Color fundus image; 2352 x 1568 pixels; 45° field of view: 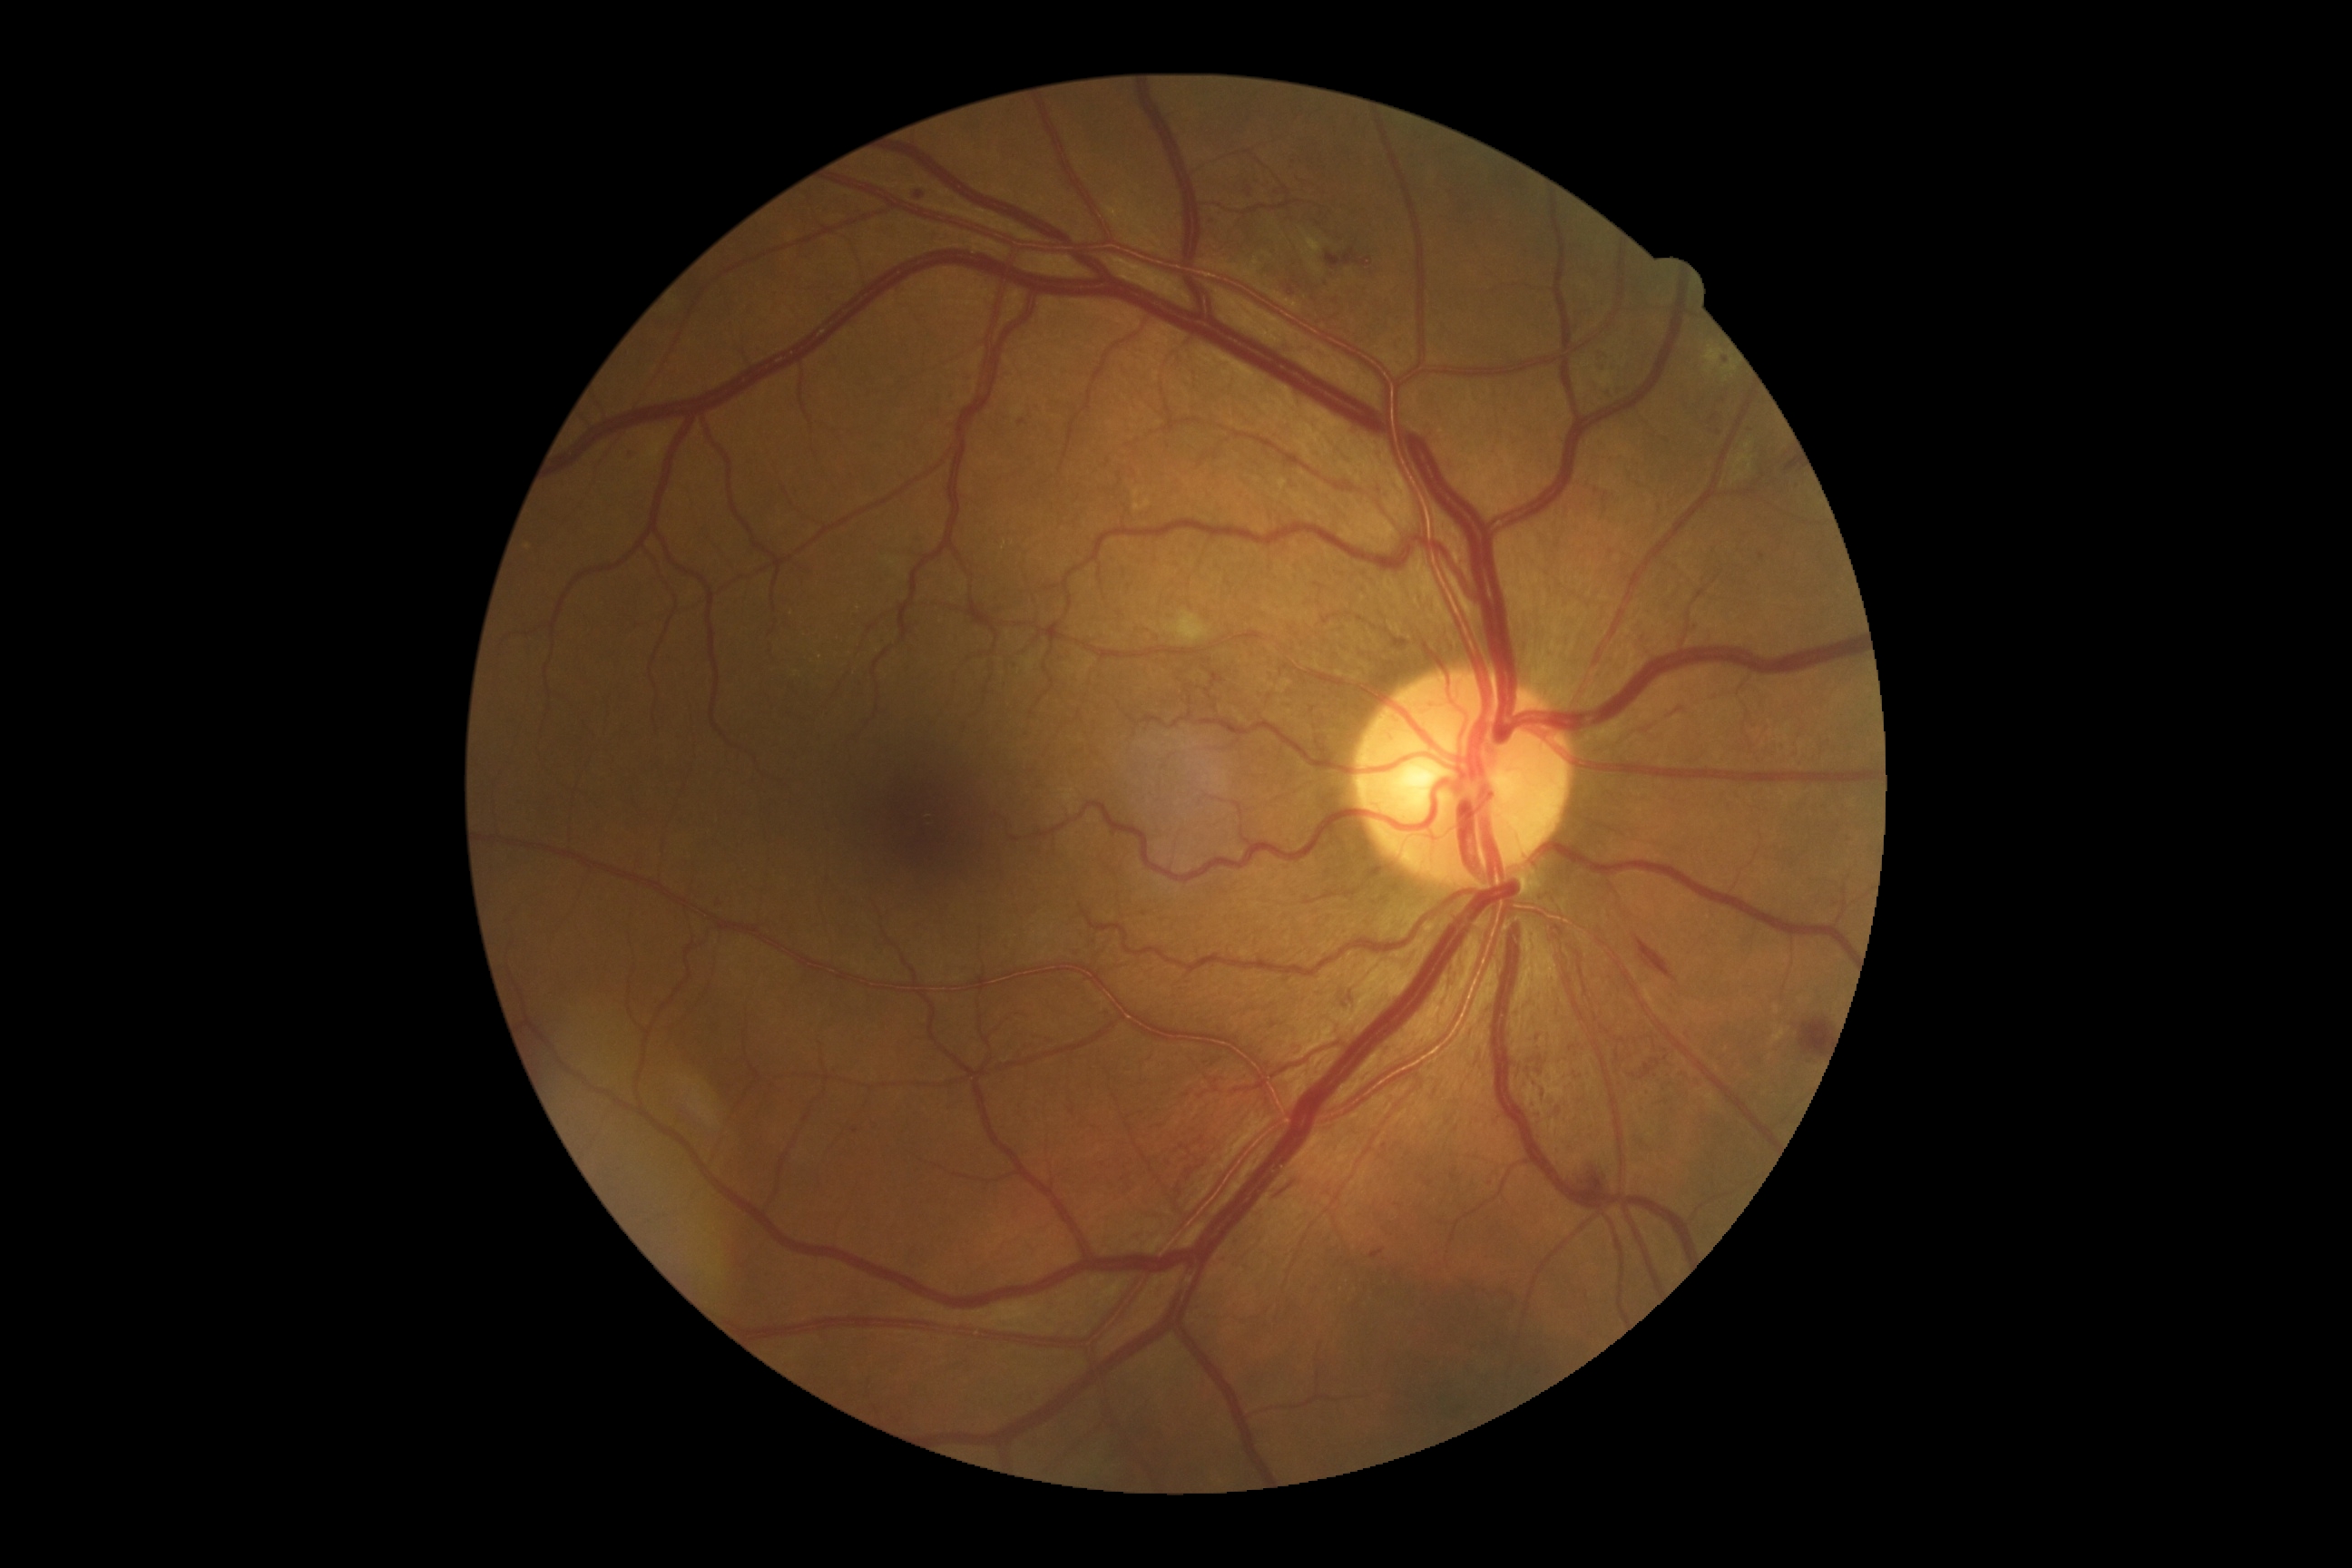 diabetic retinopathy (DR) = grade 3.